Fundus image cropped to the optic disc.
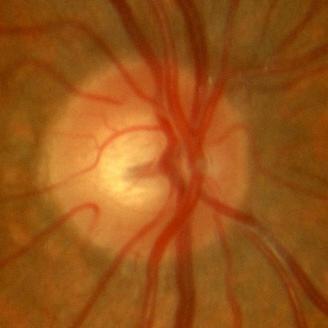
Finding: no glaucoma.